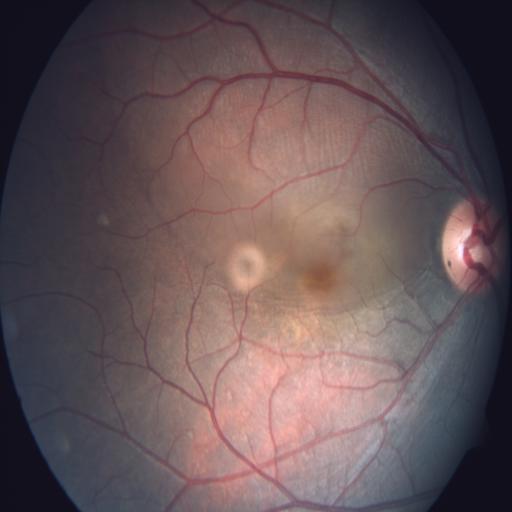 Diagnosis: central serous retinopathy (CSR).